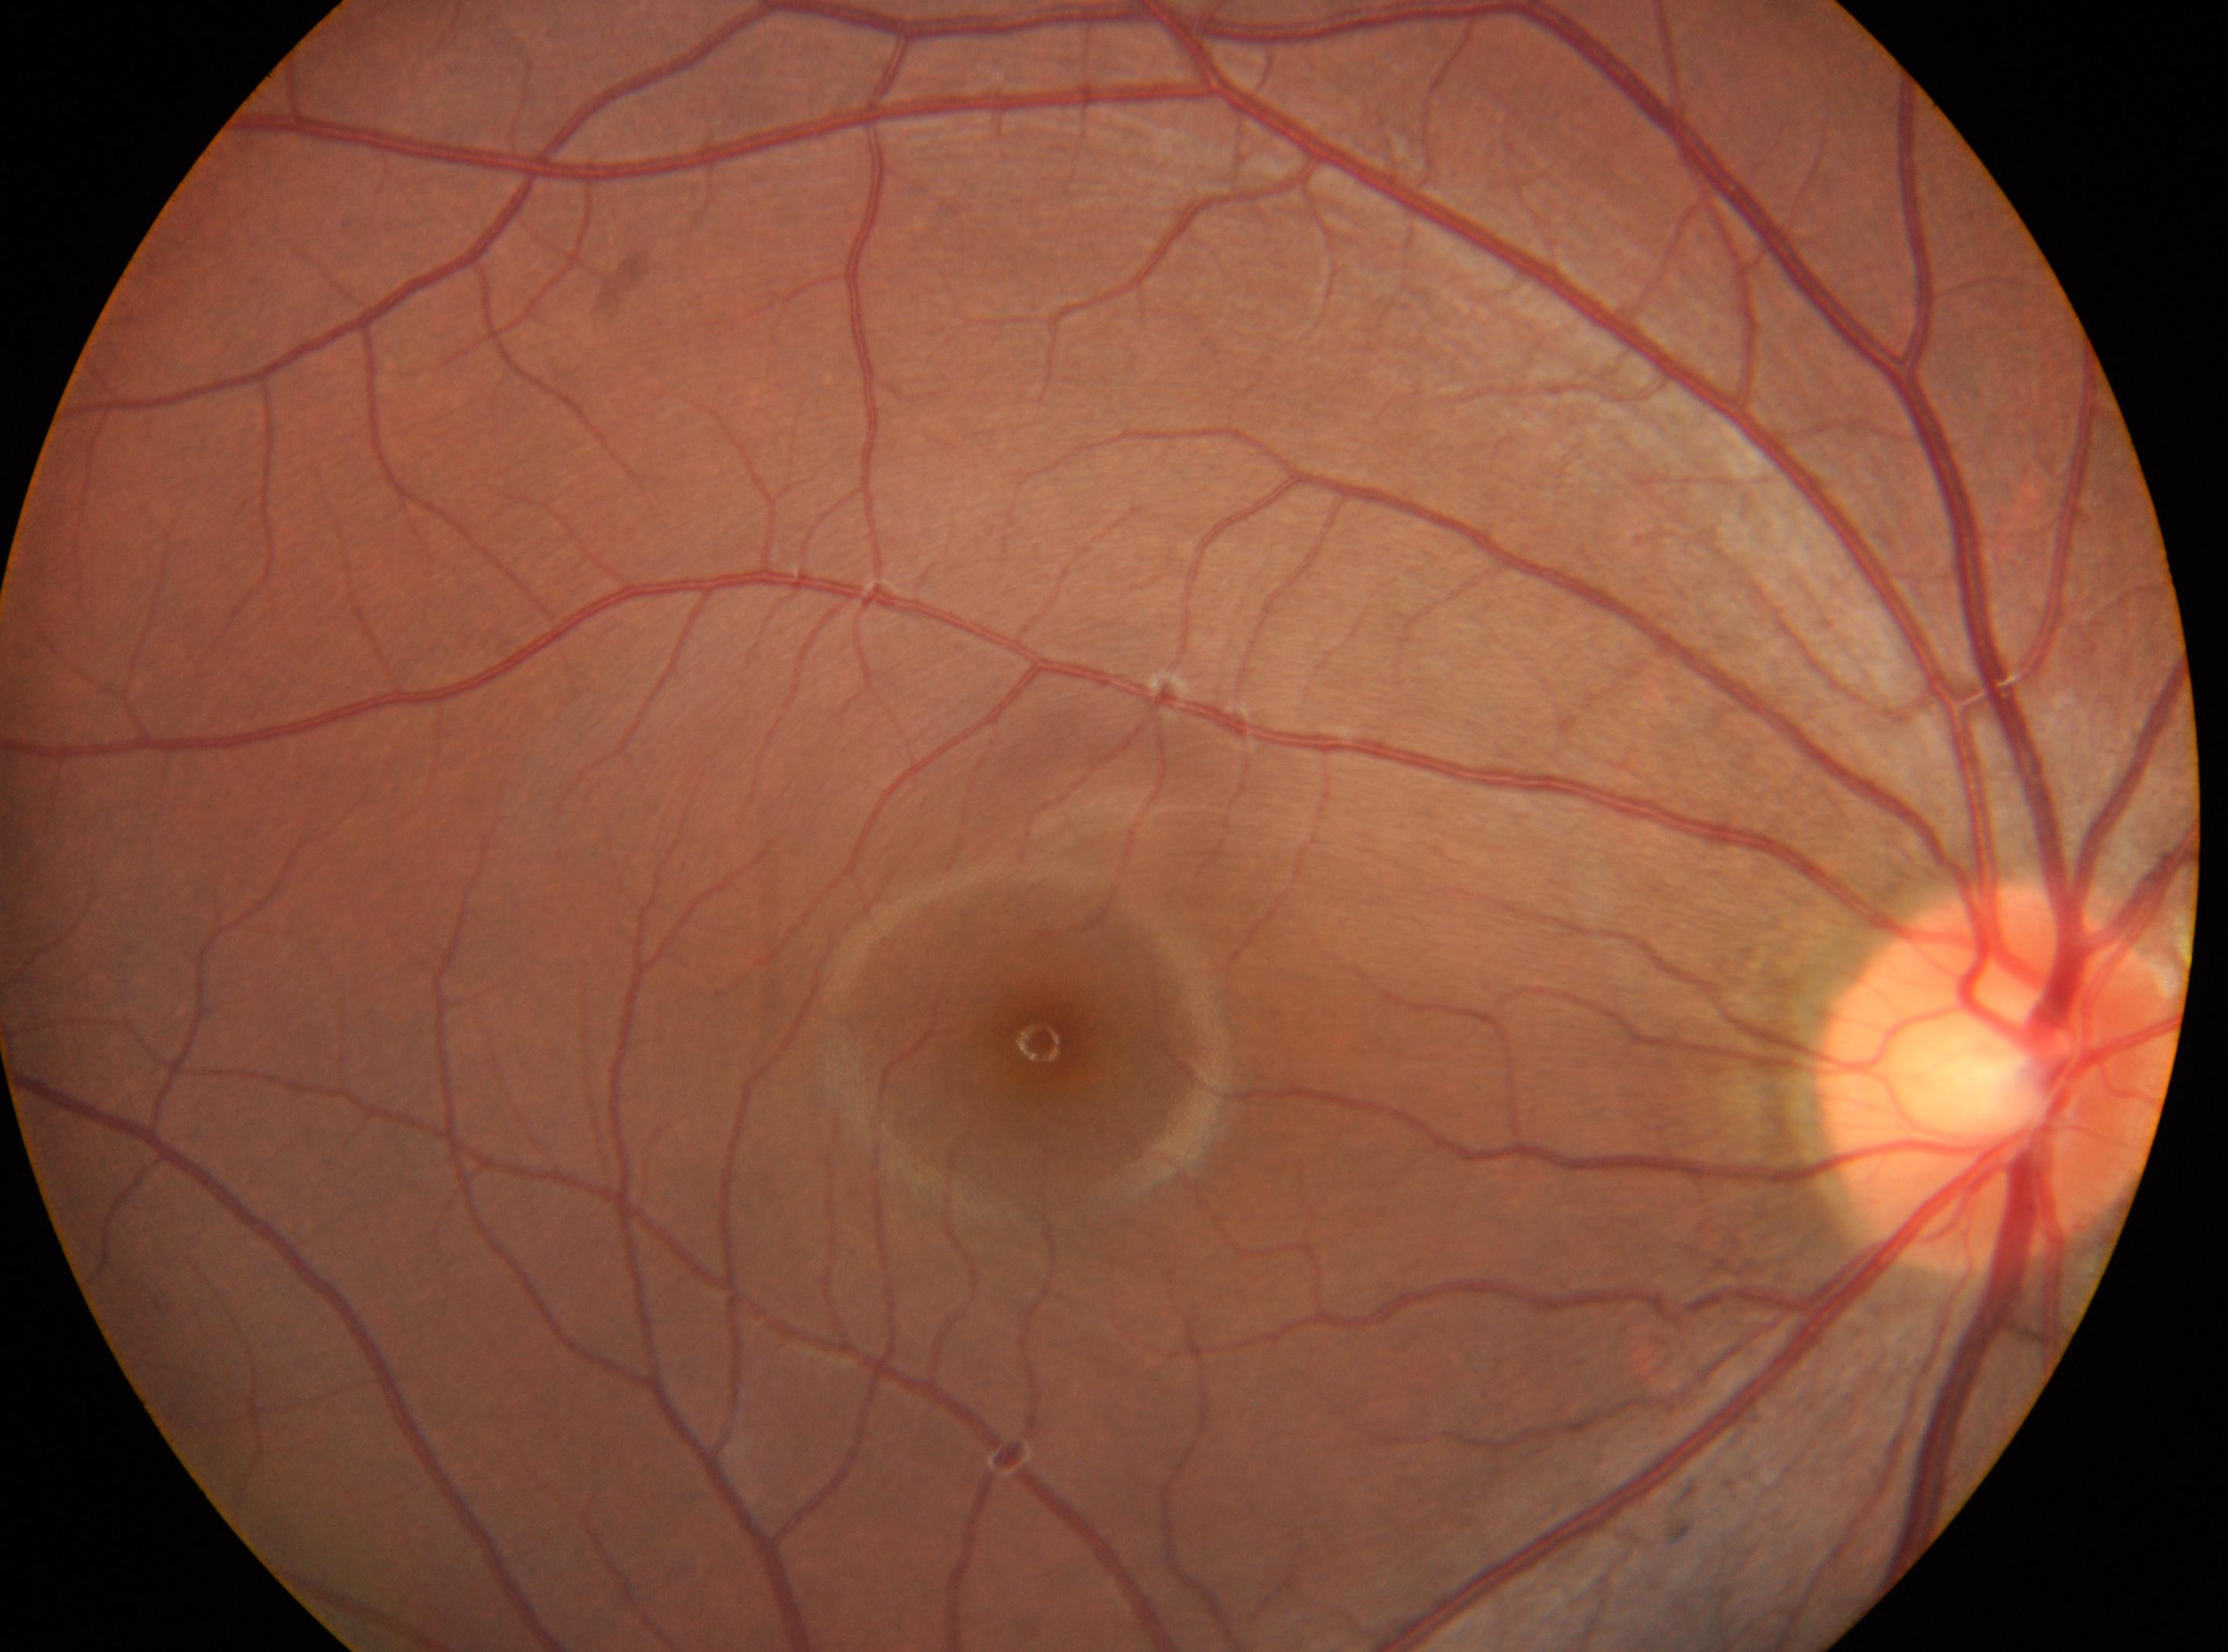 DR severity is grade 0 (no apparent retinopathy). Optic disc located at (1999,1078). The image shows the OD. The fovea center is at (1040,1043).